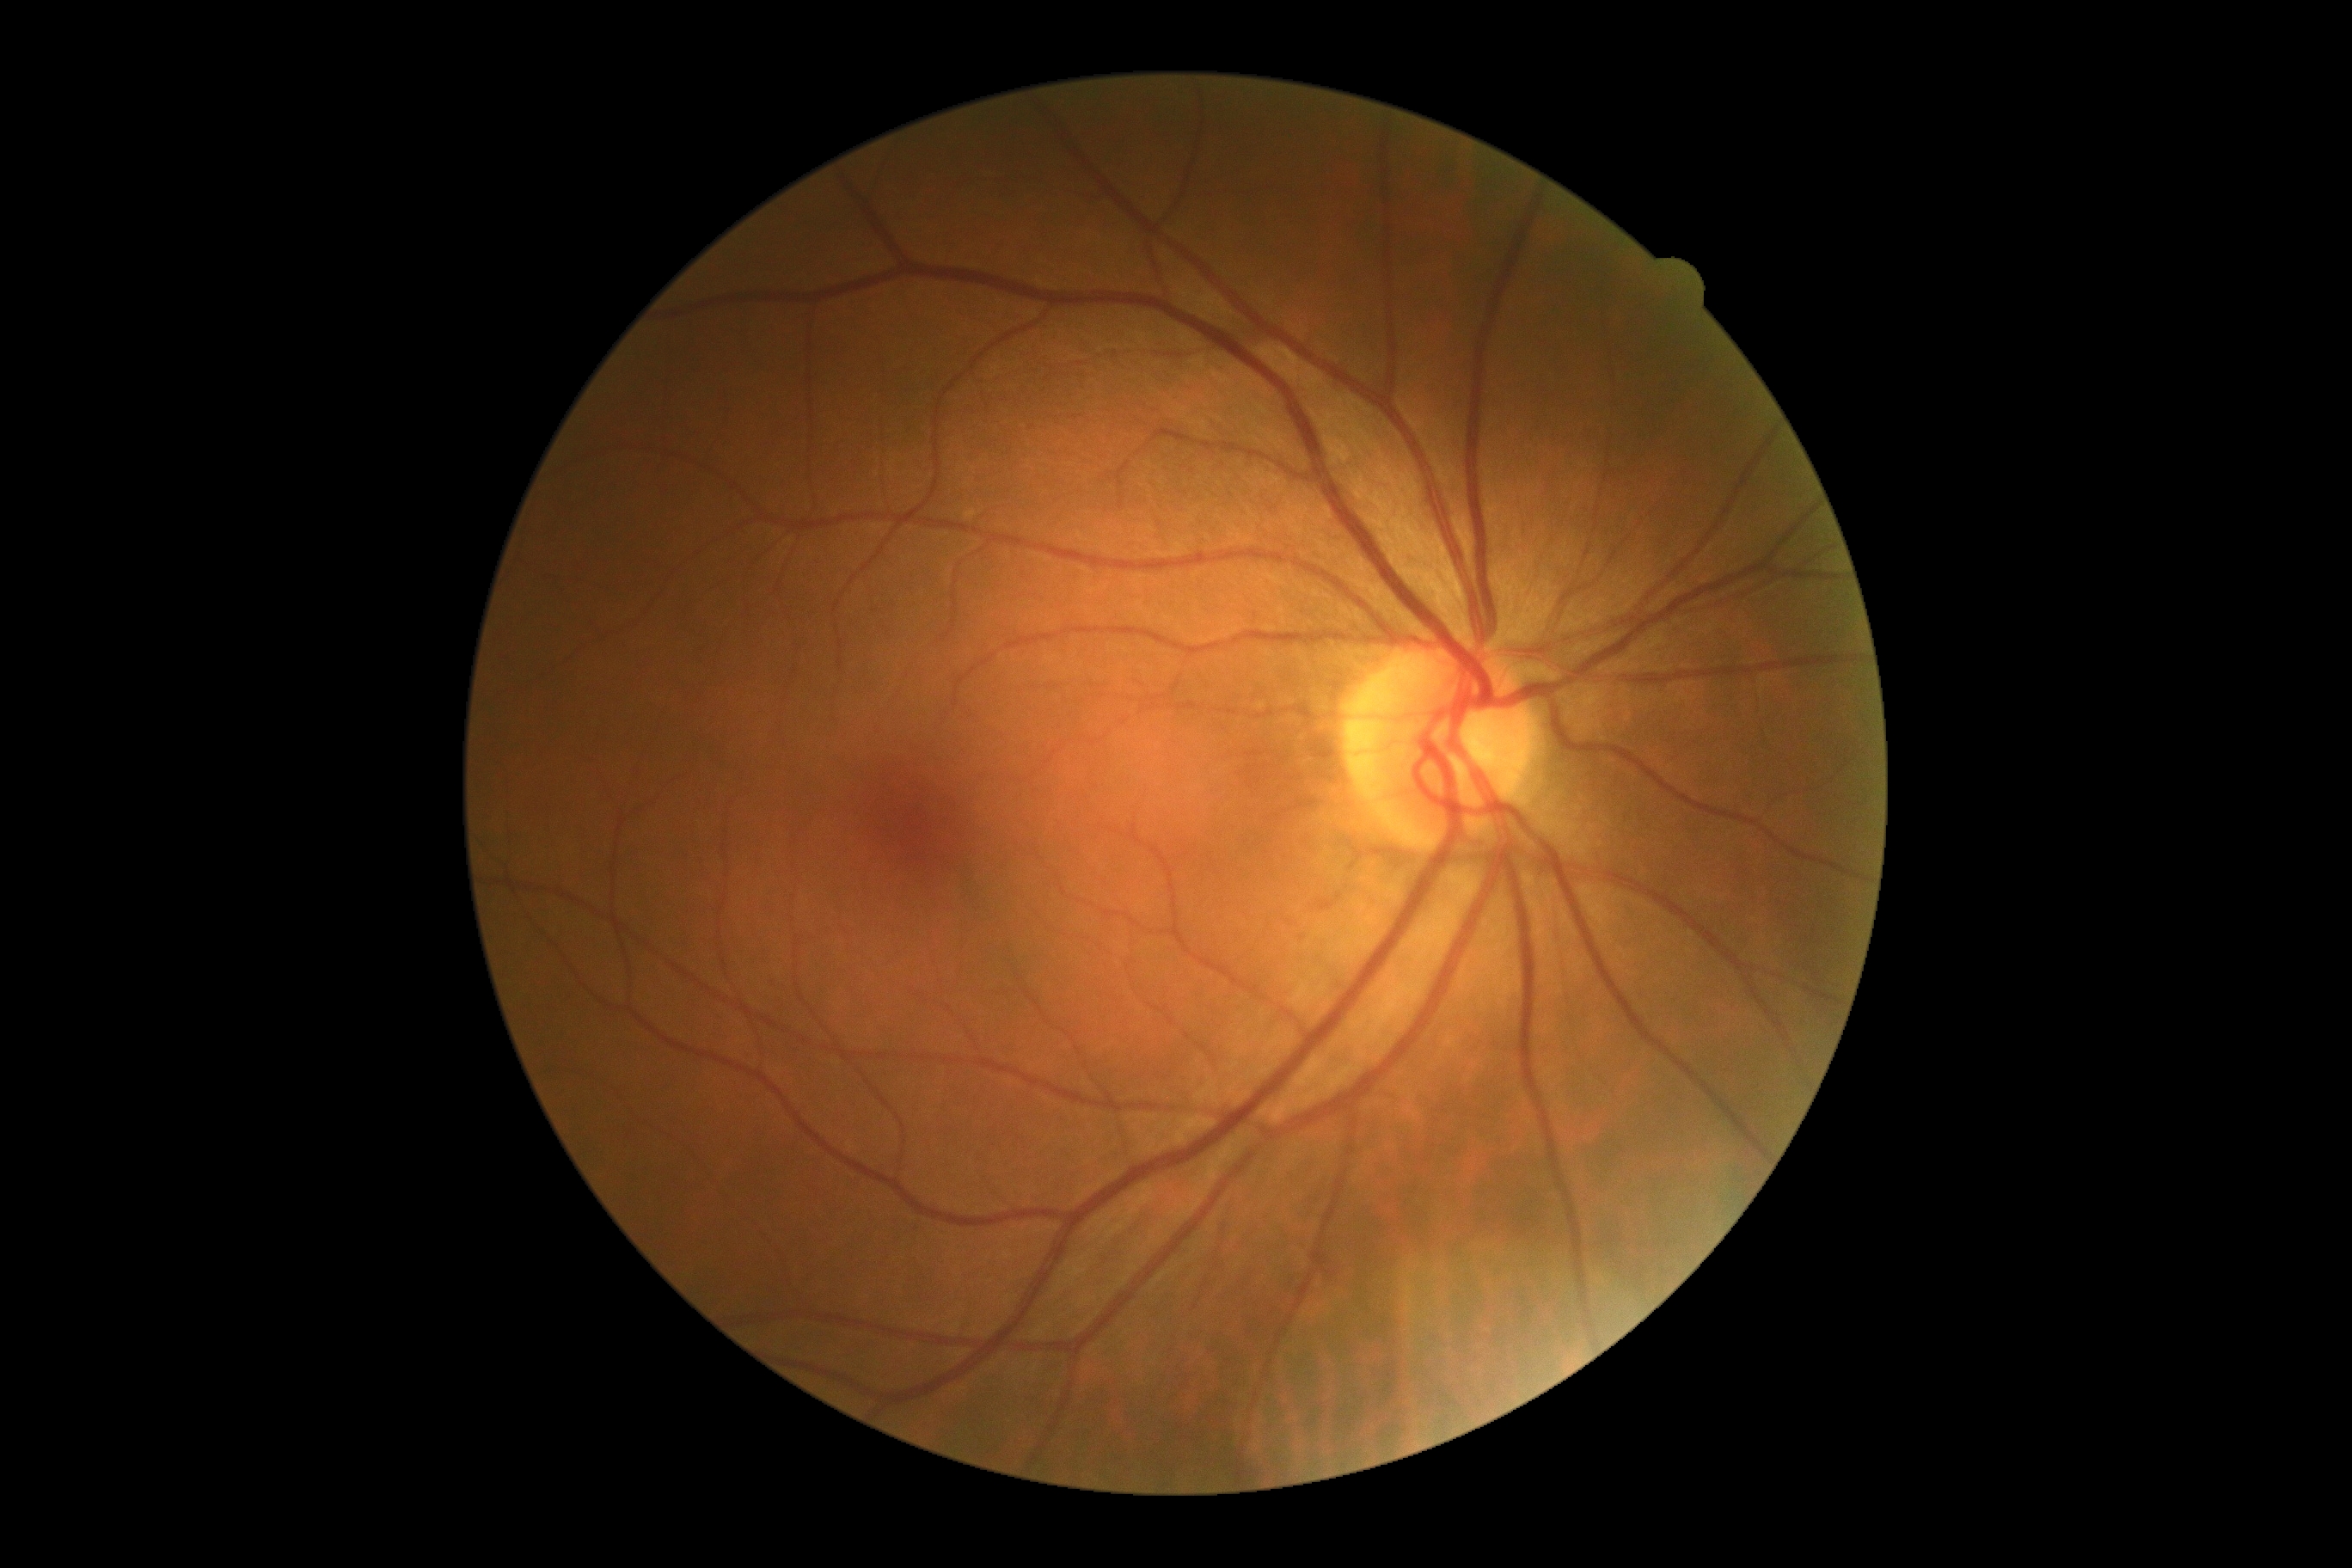

retinopathy grade: 0.